Modified Davis classification.
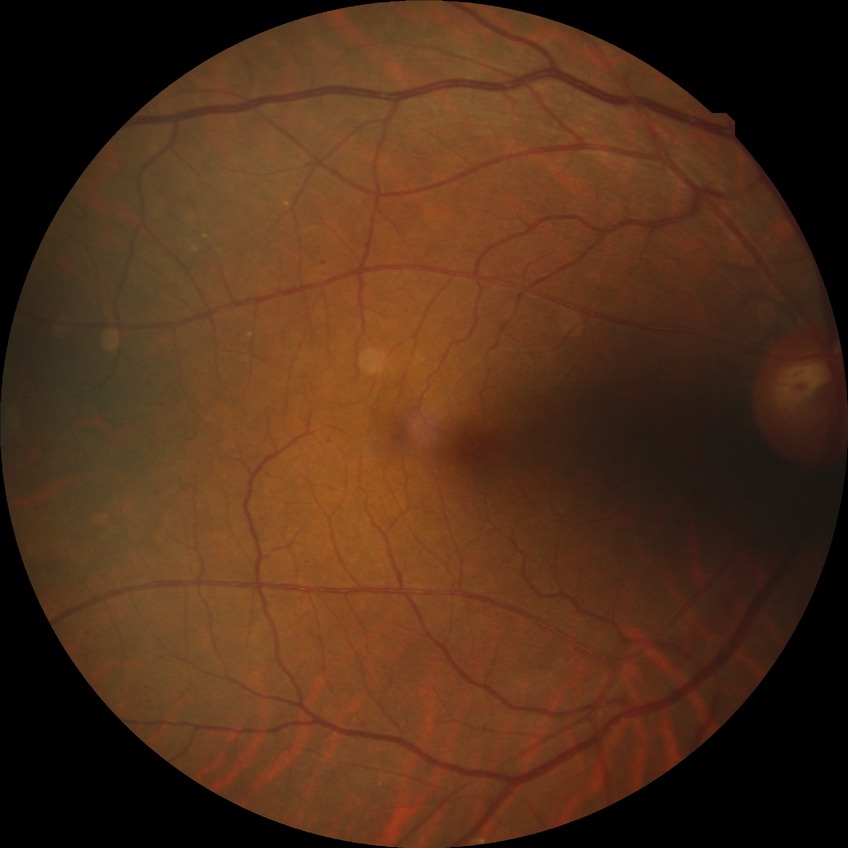

Diabetic retinopathy (DR): no diabetic retinopathy (NDR).